Phoenix ICON, 100° FOV · infant wide-field retinal image · 1240 x 1240 pixels
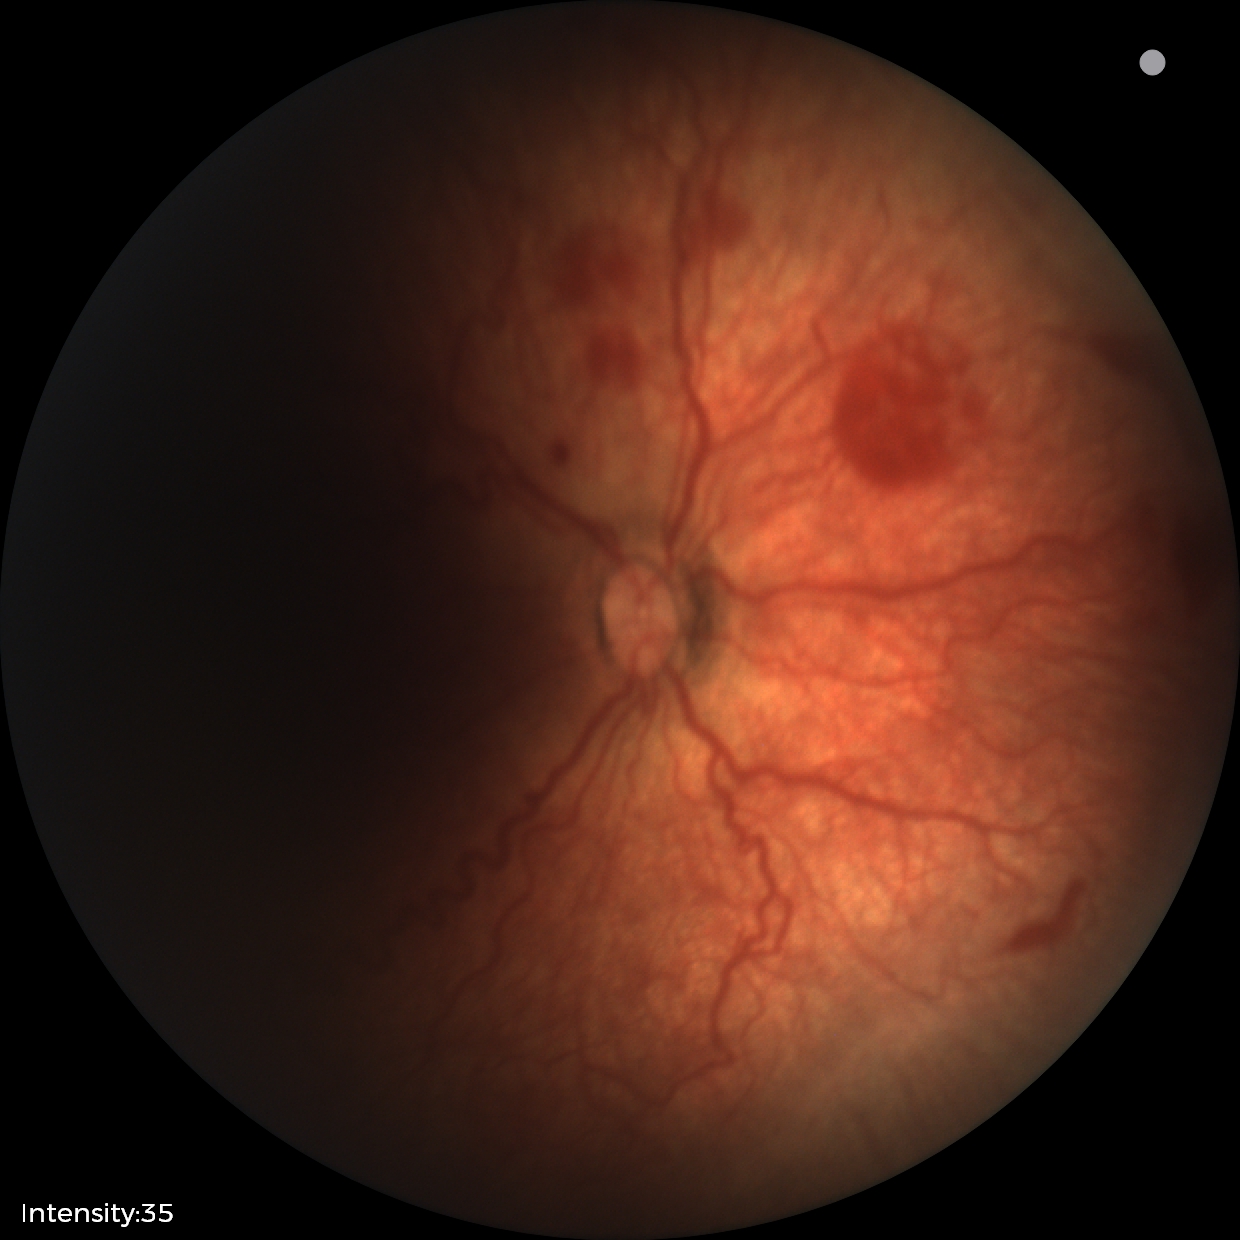 From an examination with diagnosis of retinopathy of prematurity stage 2 — ridge with height and width at the demarcation line.